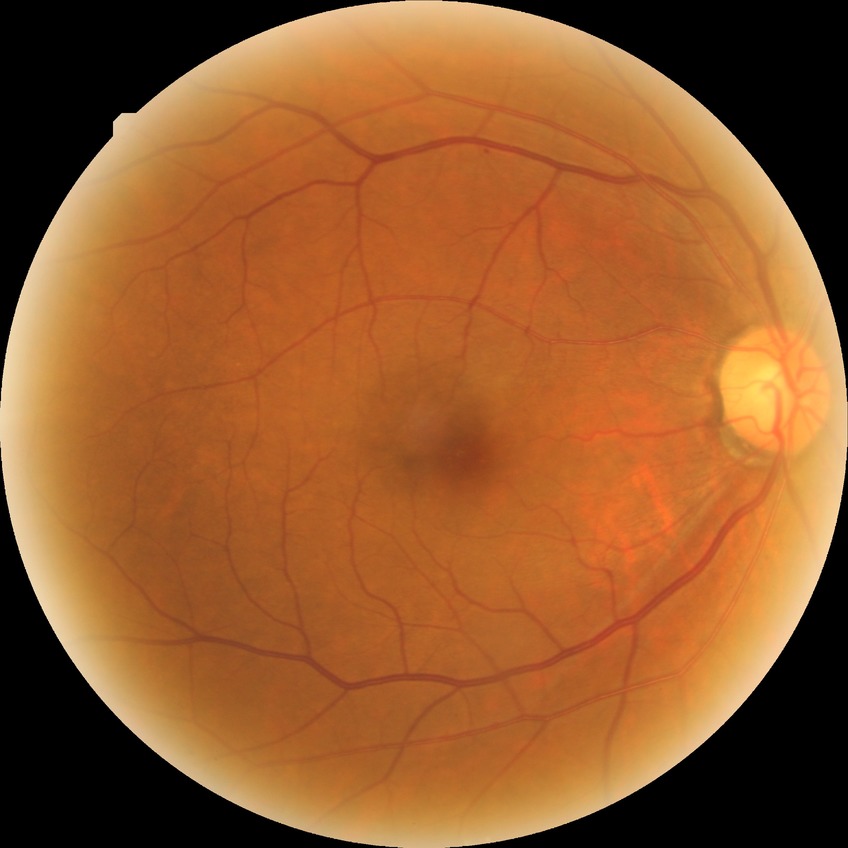

  davis_grade: simple diabetic retinopathy (SDR)
  proliferative_class: non-proliferative diabetic retinopathy